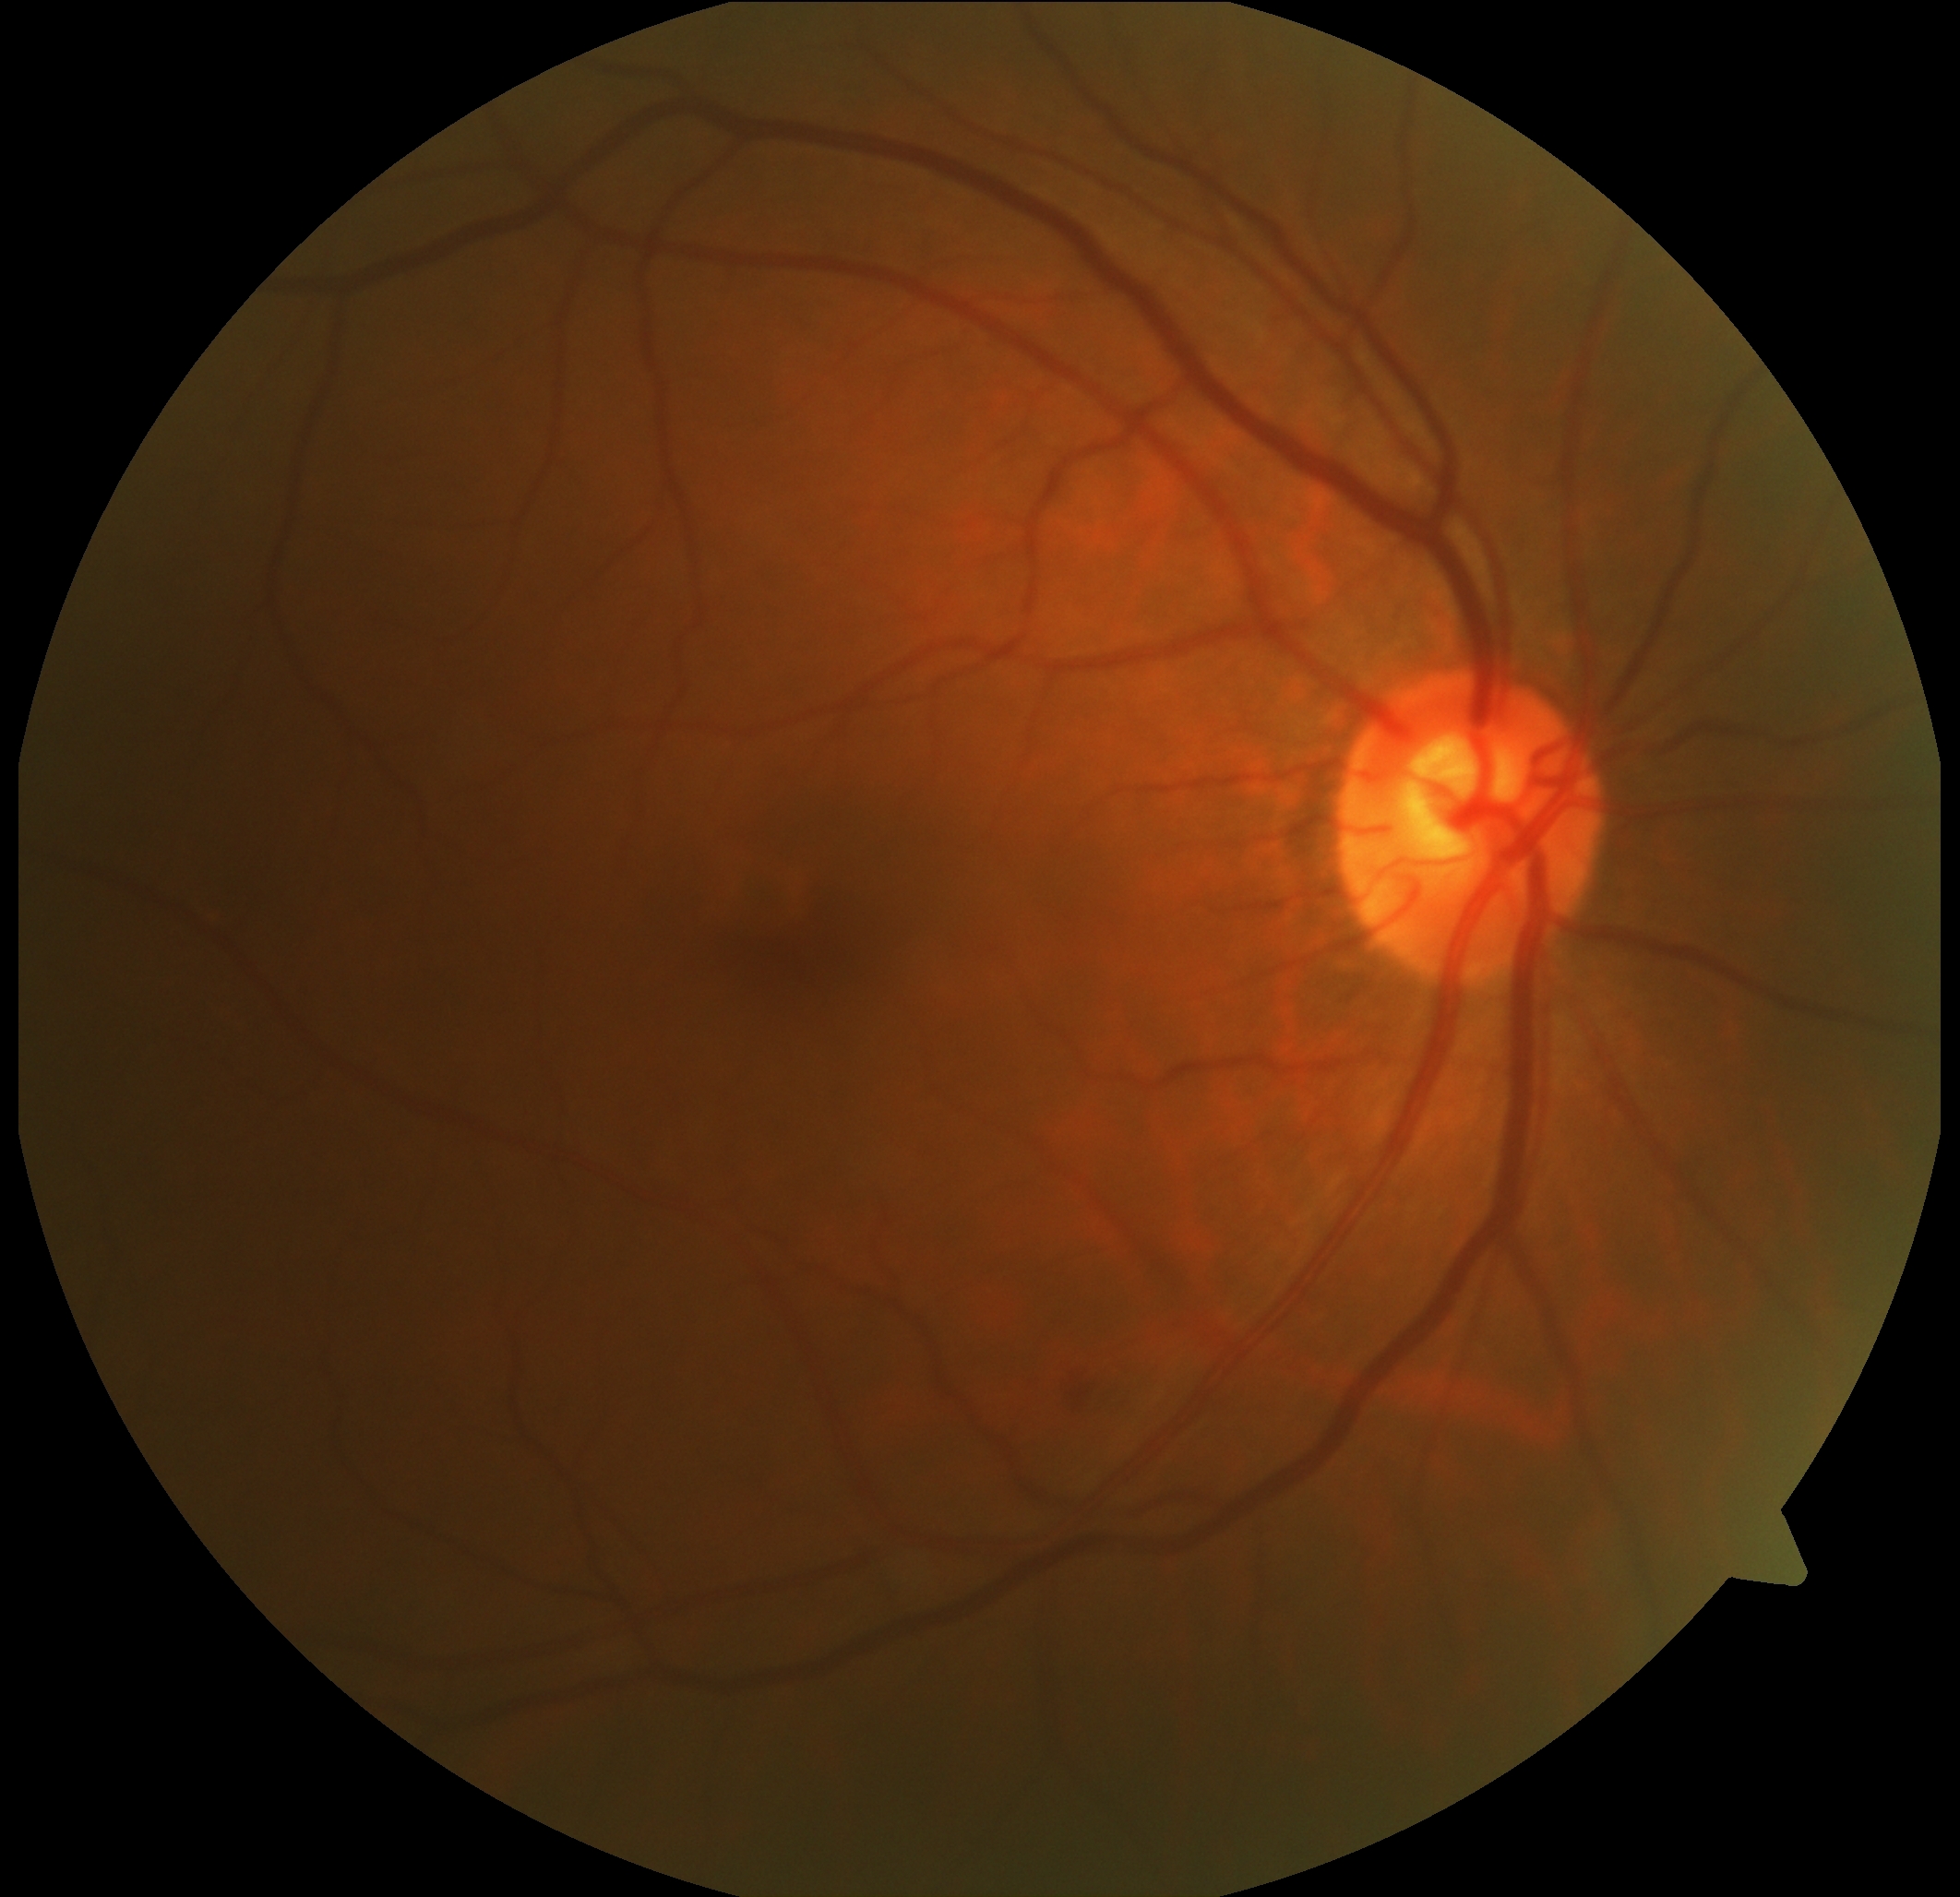 DR class = non-proliferative diabetic retinopathy, retinopathy = grade 2 (moderate NPDR).